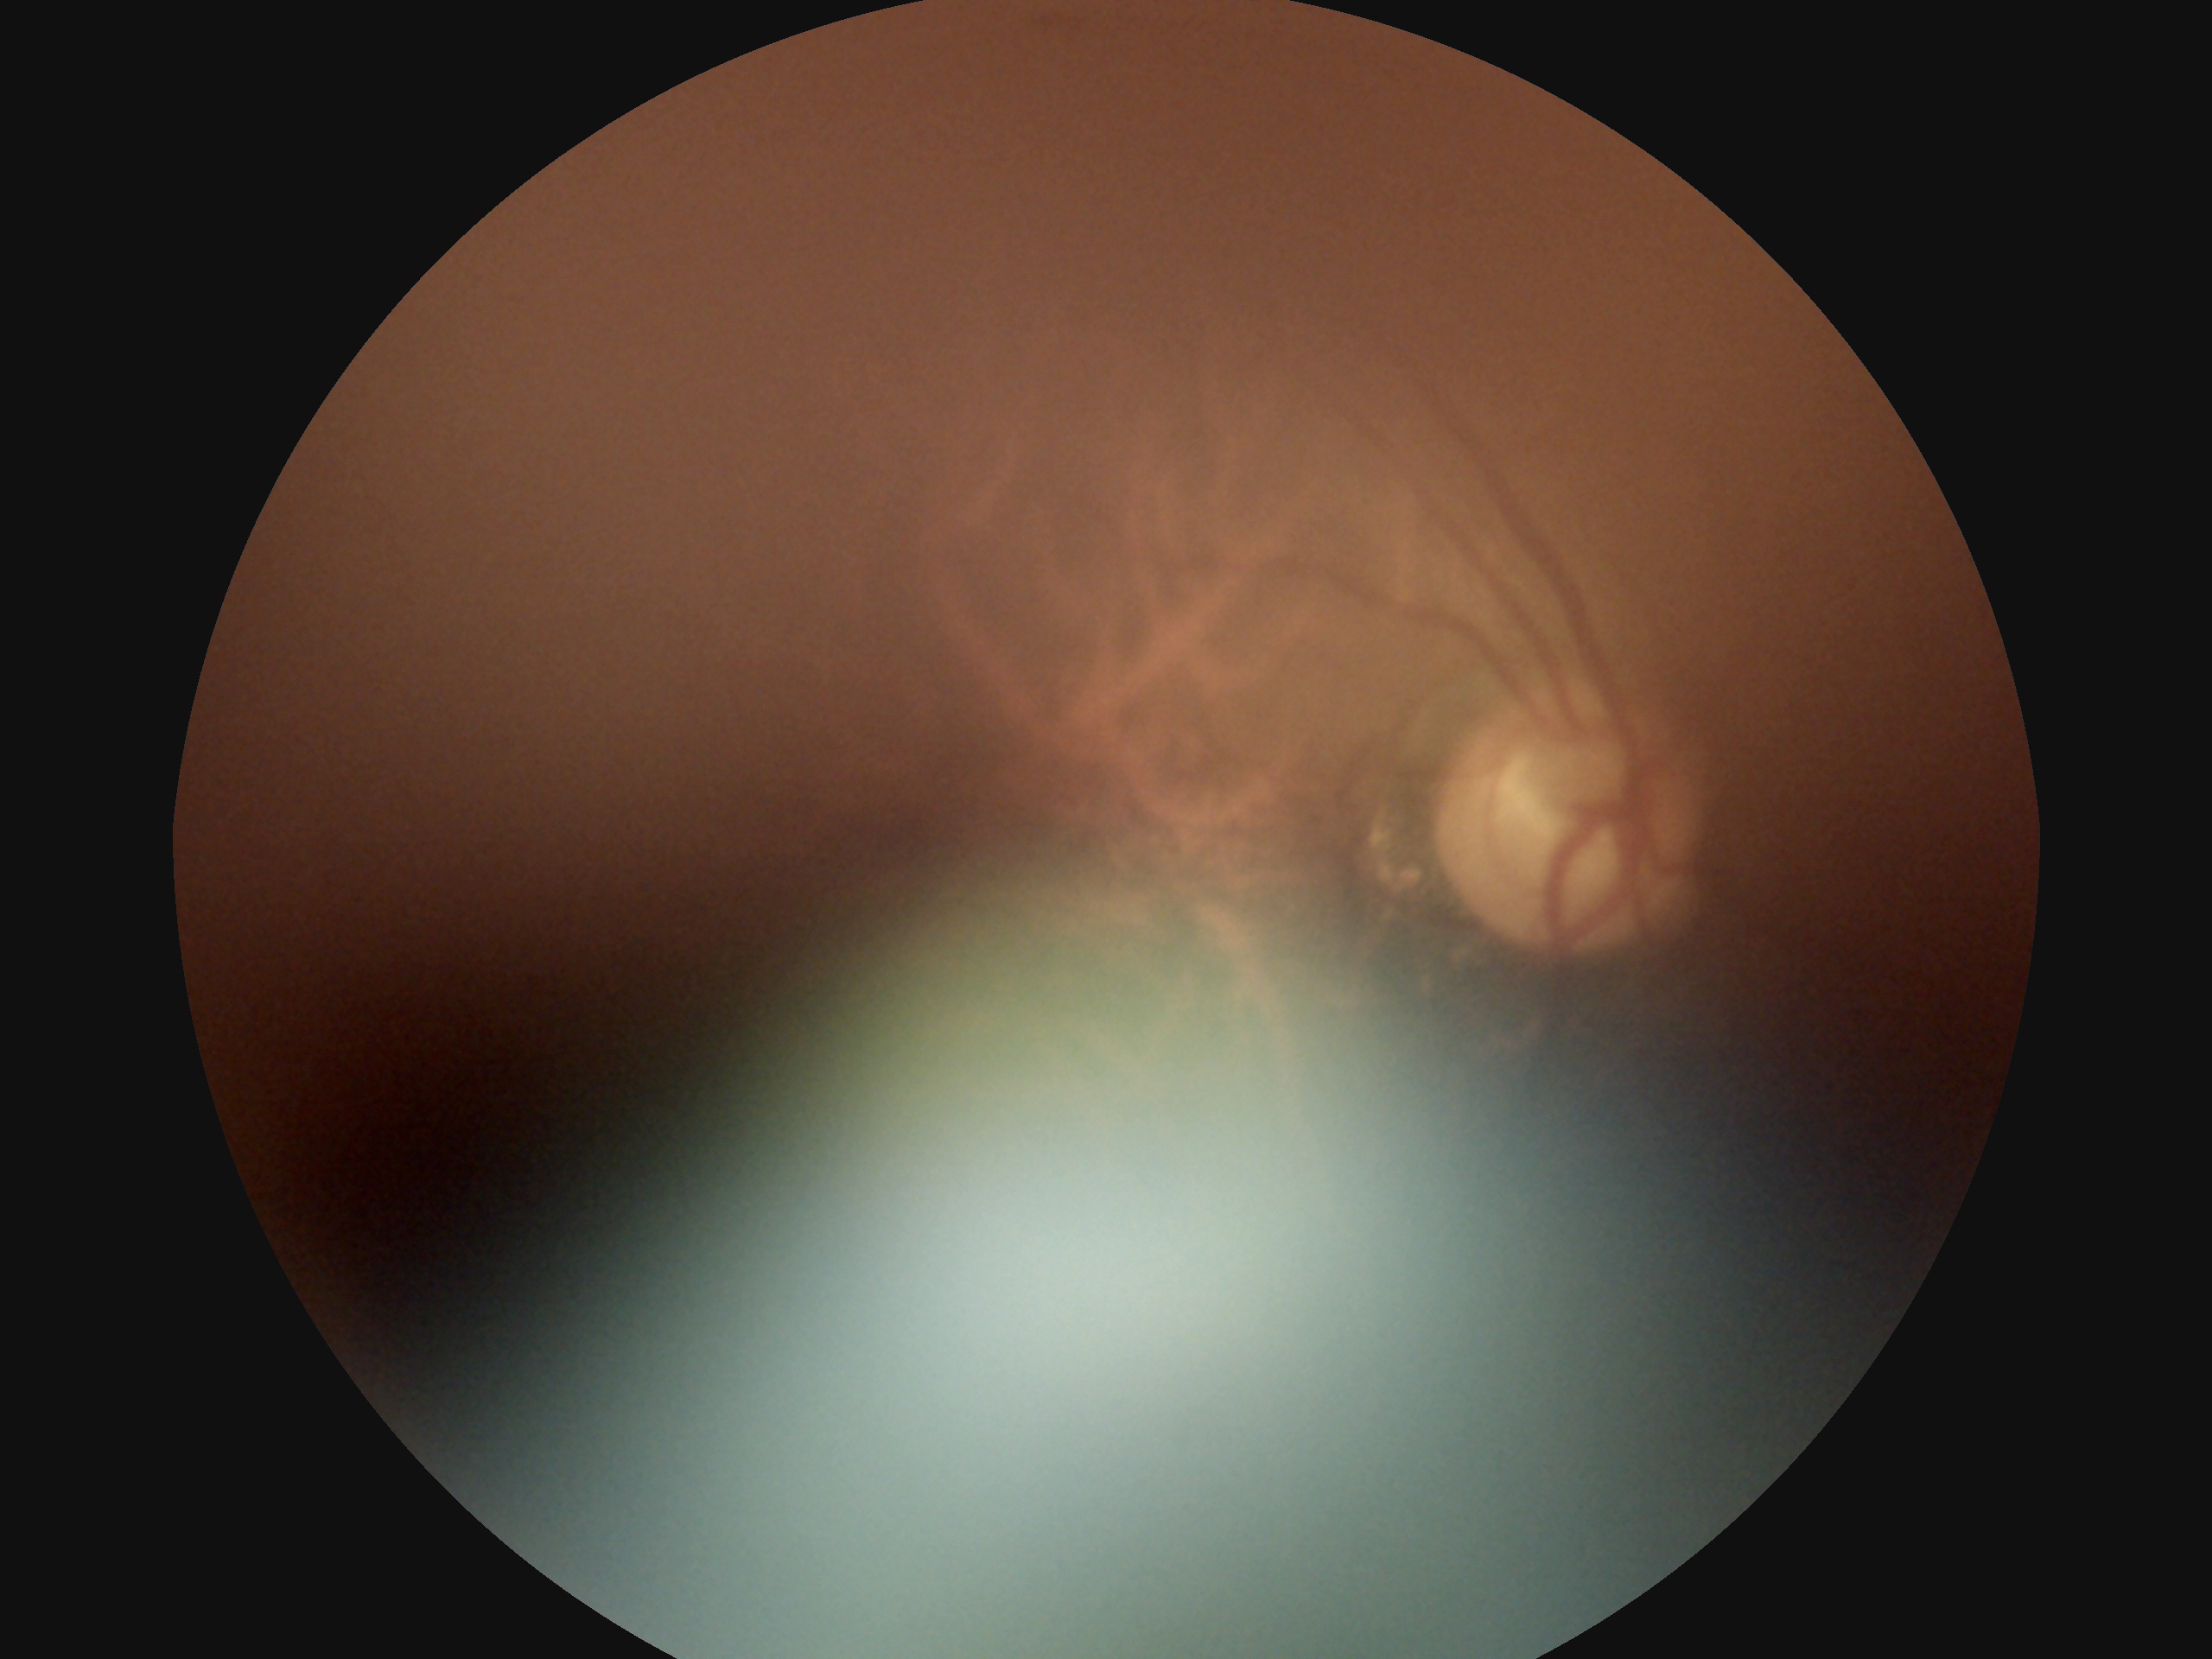 Diabetic retinopathy (DR): ungradable due to poor image quality.